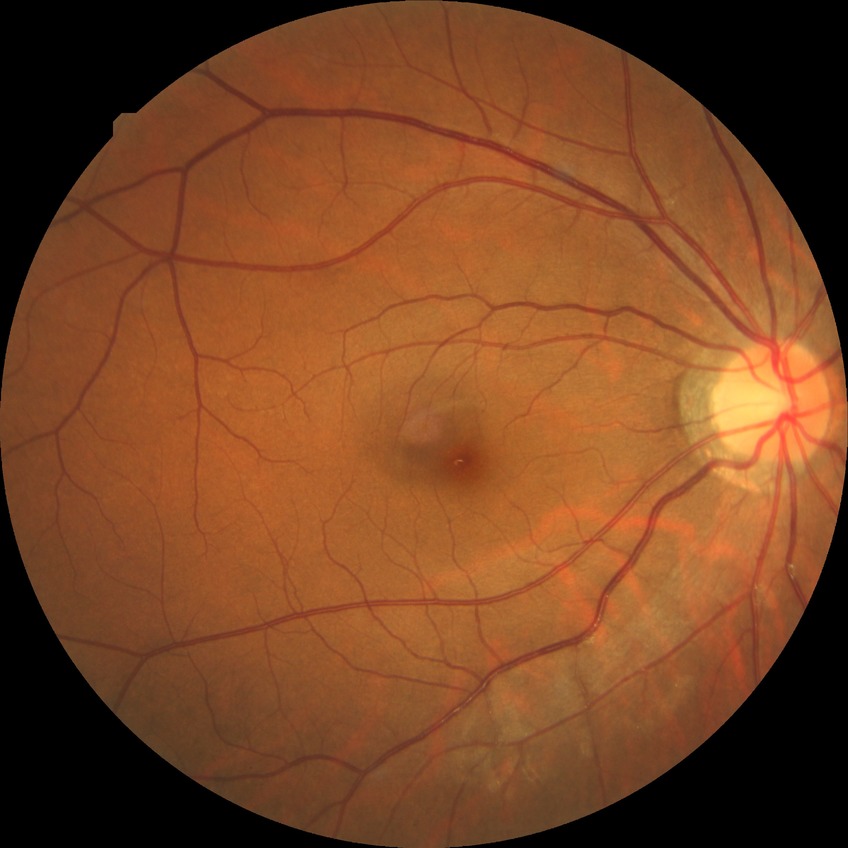 retinopathy stage: no diabetic retinopathy.